Color fundus image, 45° field of view, 728 x 709 pixels — 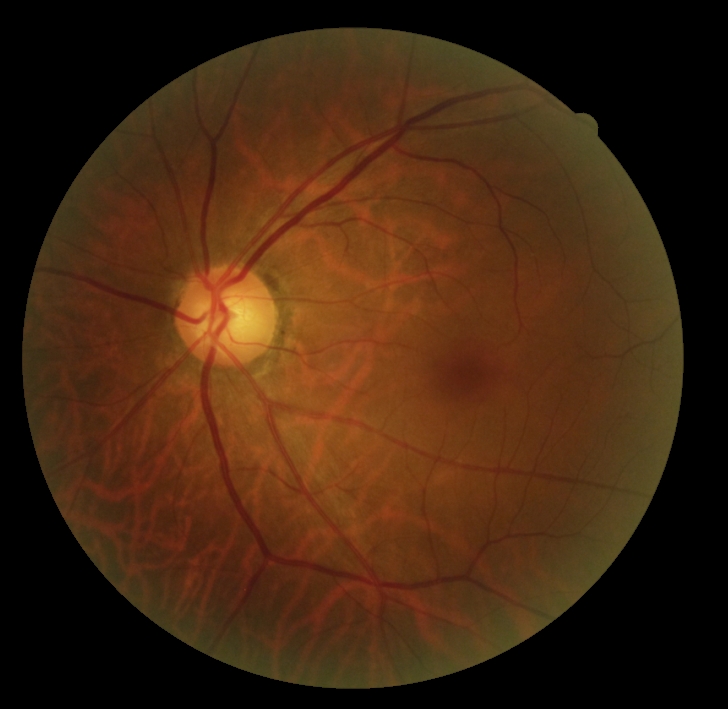

DR stage: 0. No signs of diabetic retinopathy.